45° field of view, color fundus photograph:
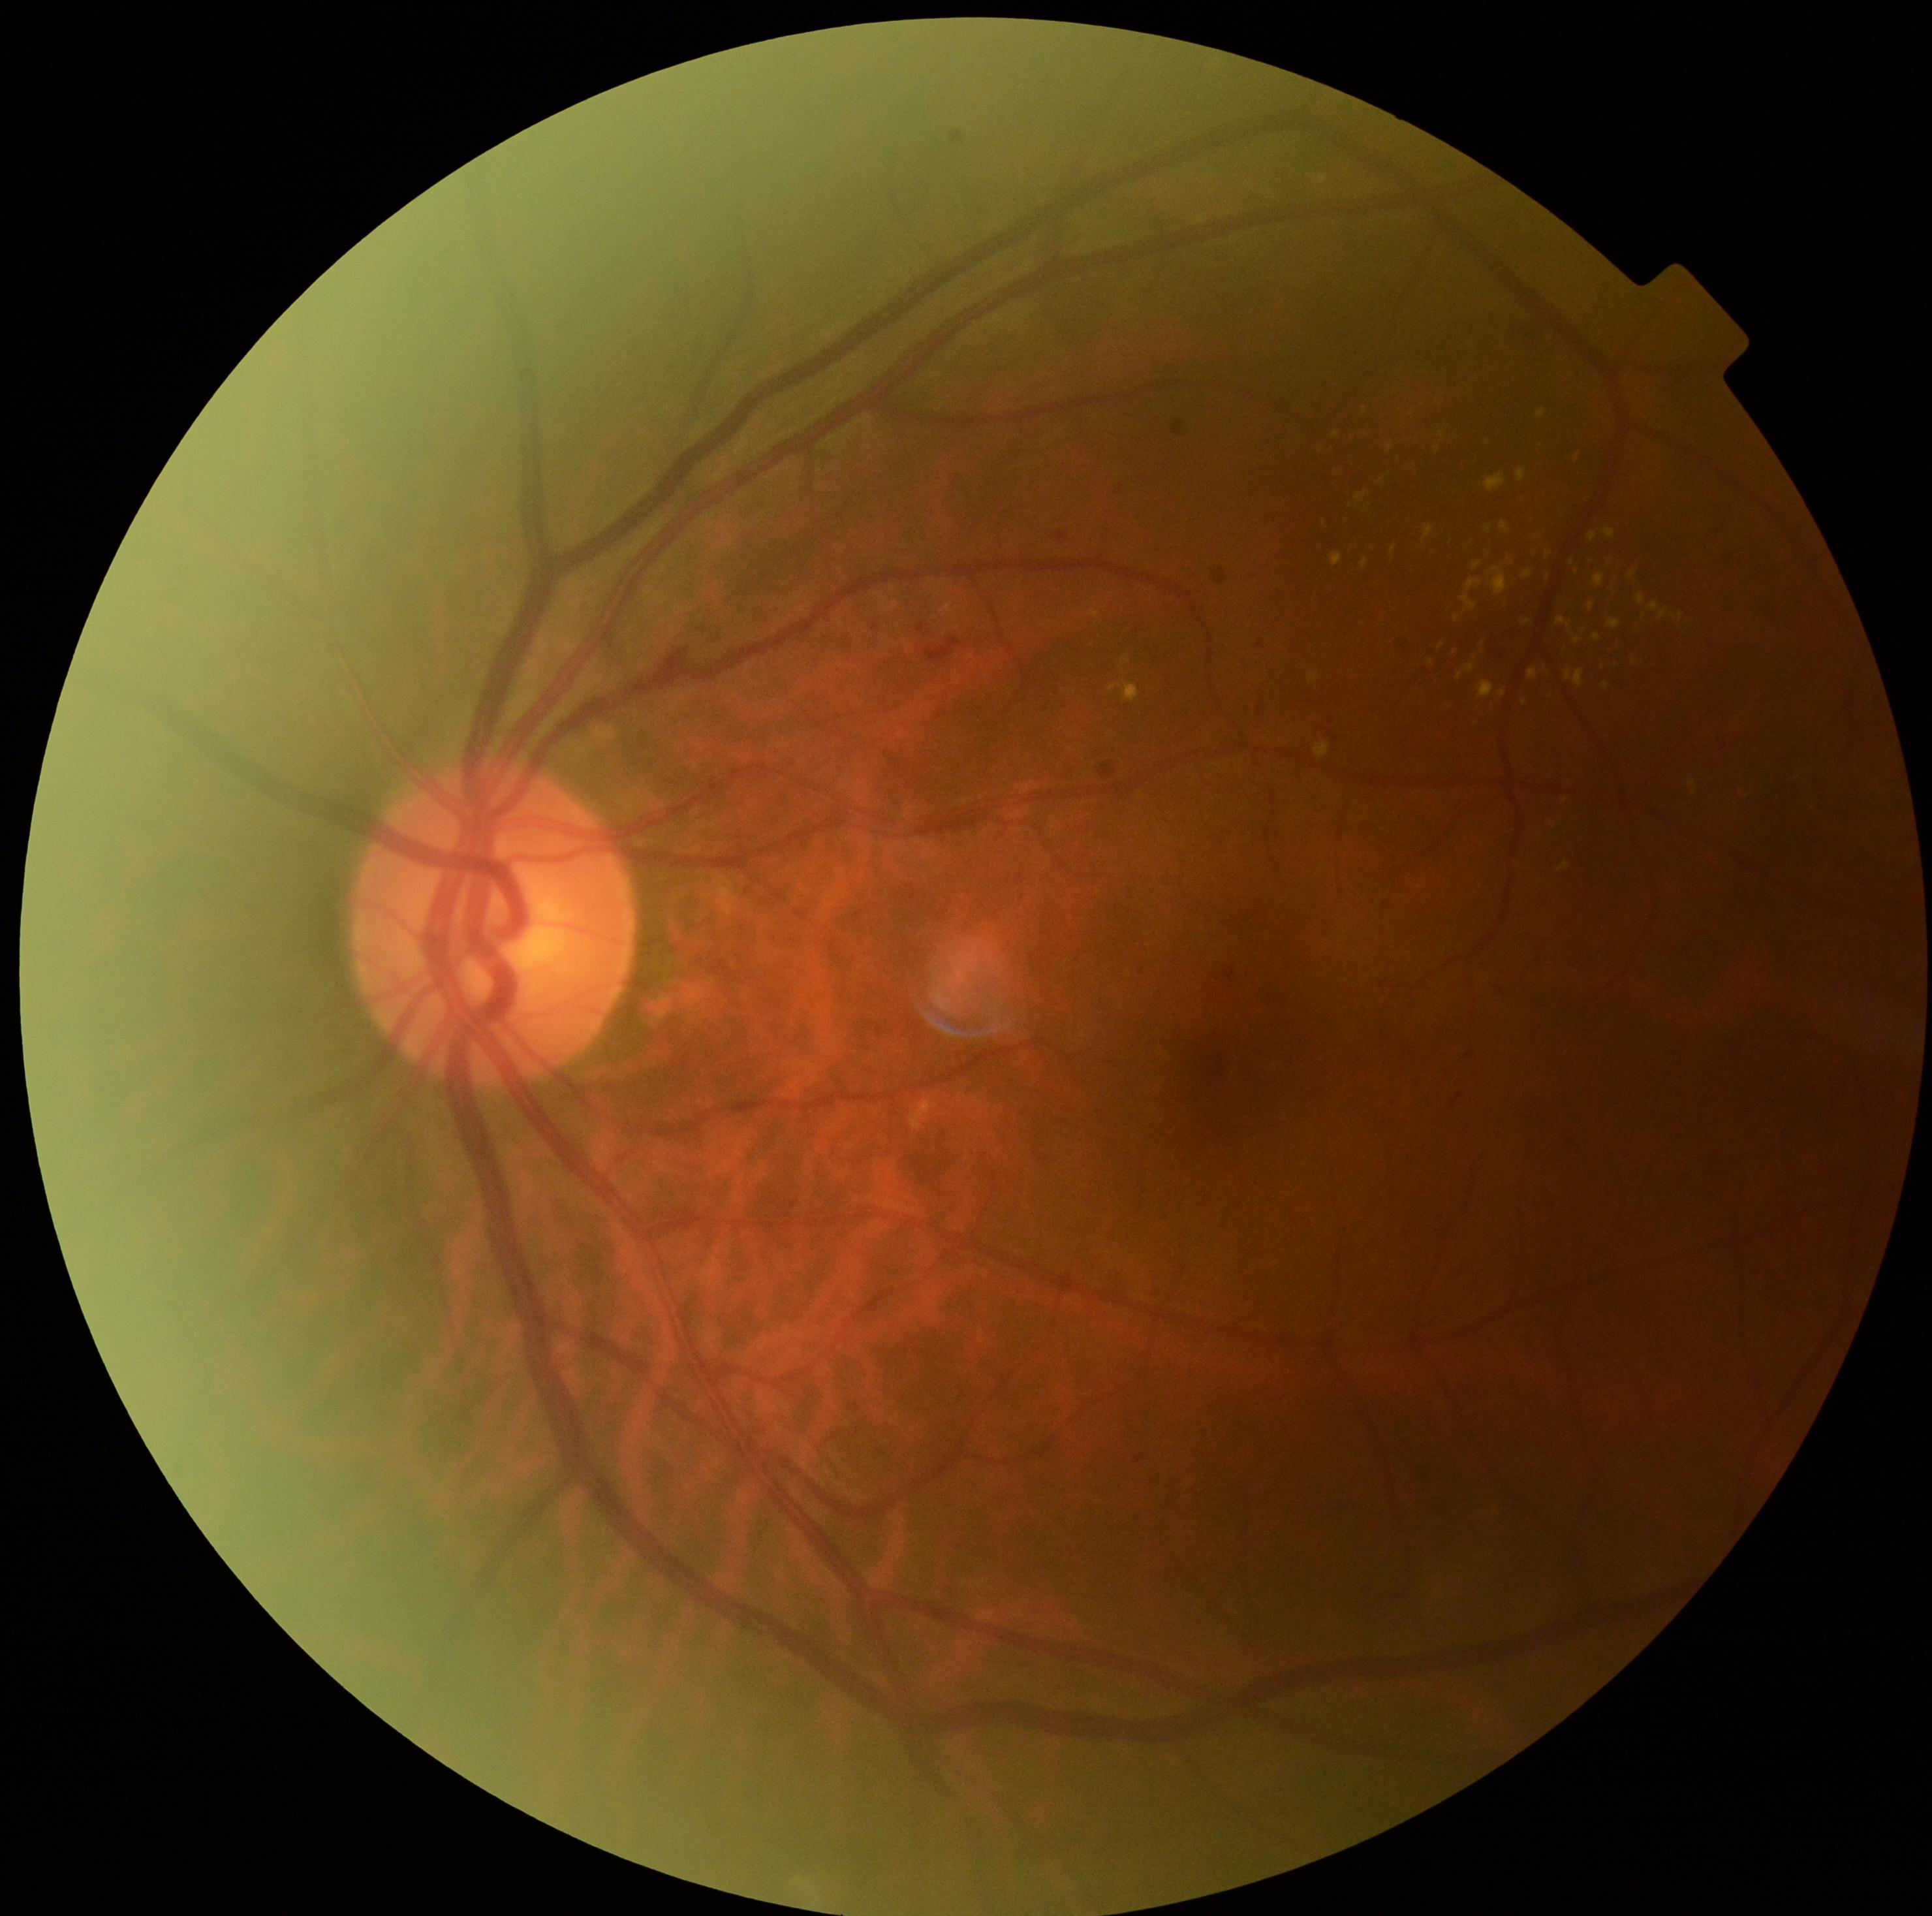 {"dr_category": "non-proliferative diabetic retinopathy", "dr_grade": "grade 2"}